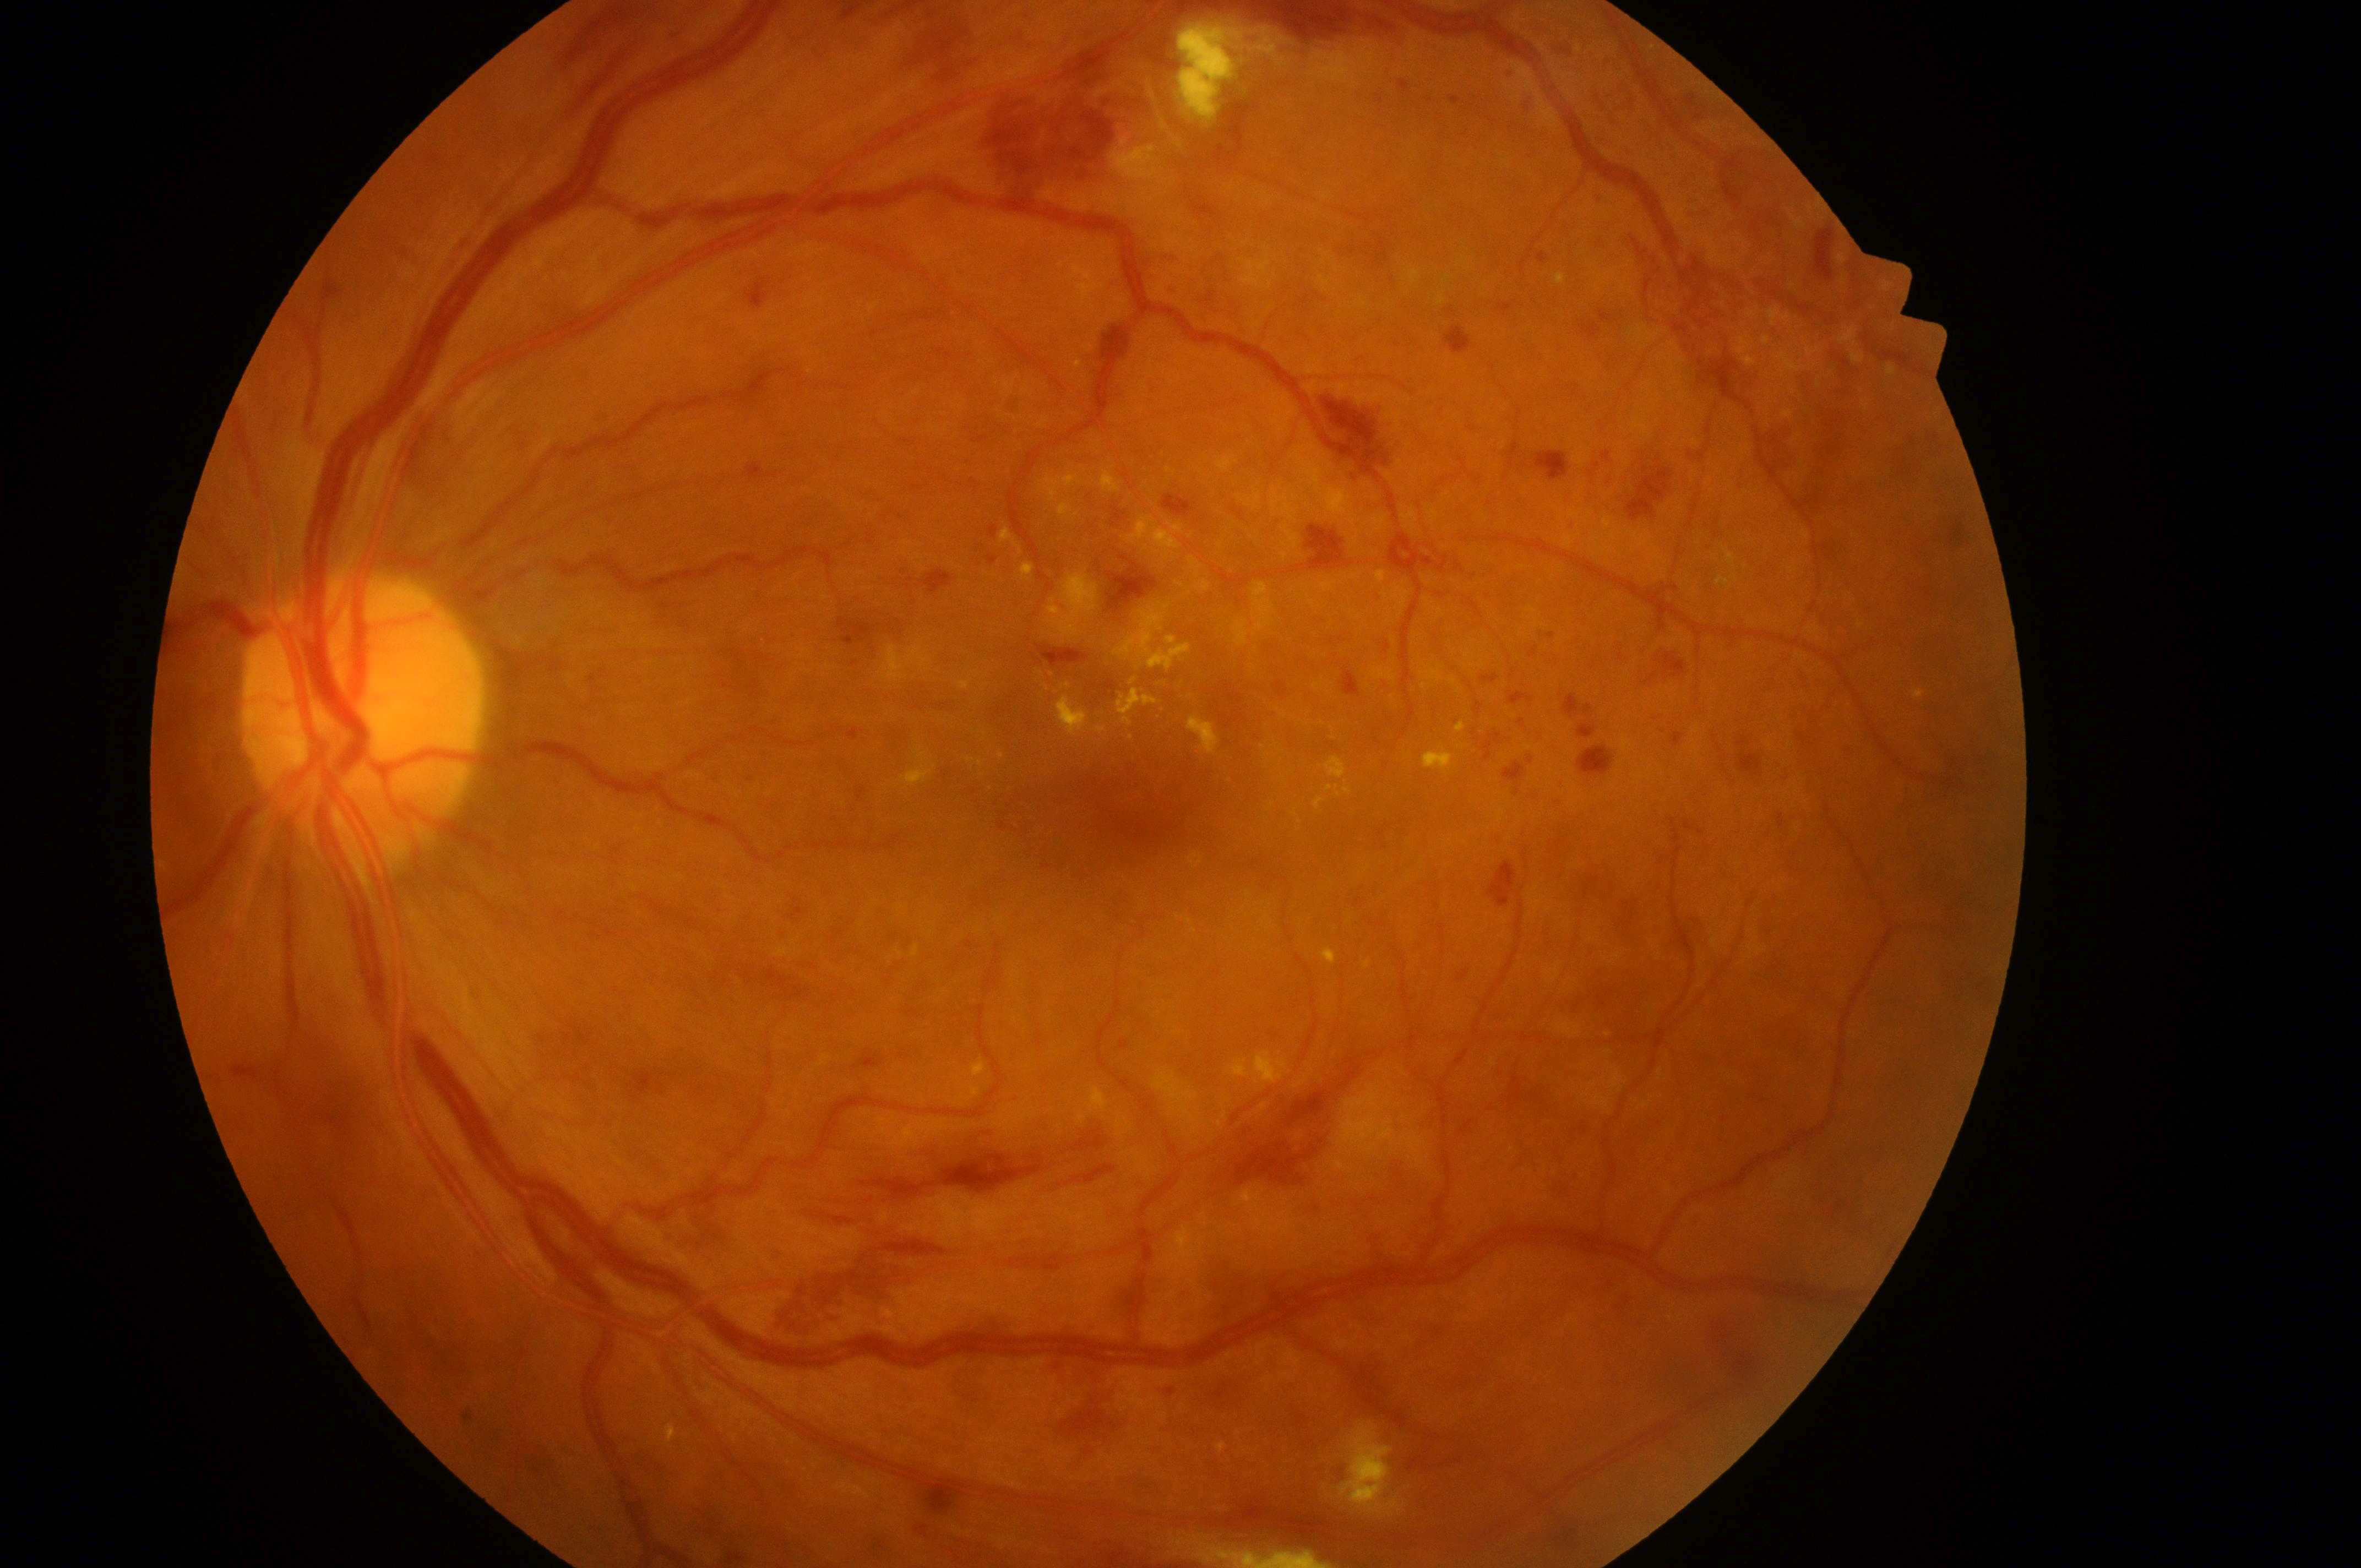

Fovea center located at (1134, 812). DR severity: PDR (grade 4). Optic disc located at (352, 721). Eye: left. DME risk: grade 2 (high risk). Disease class: proliferative diabetic retinopathy.